NIDEK AFC-230 fundus camera. Retinal fundus photograph. Nonmydriatic — 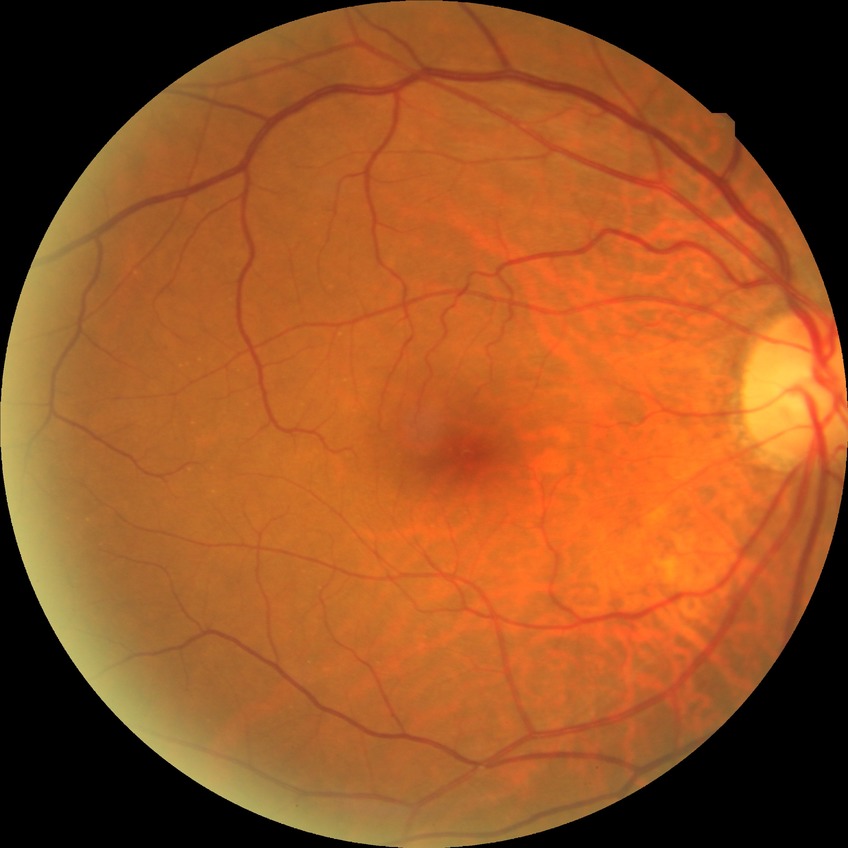
Diabetic retinopathy severity is simple diabetic retinopathy. DR class: non-proliferative diabetic retinopathy.